640x480 · infant wide-field fundus photograph — 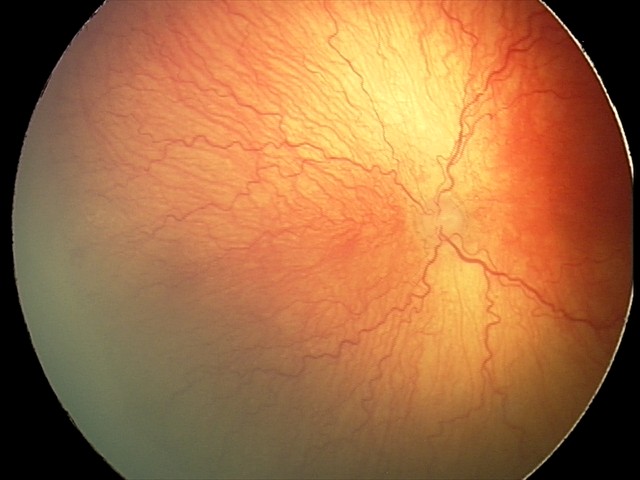

Plus disease was diagnosed. Diagnosis from this screening exam: aggressive retinopathy of prematurity.